Color fundus photograph: 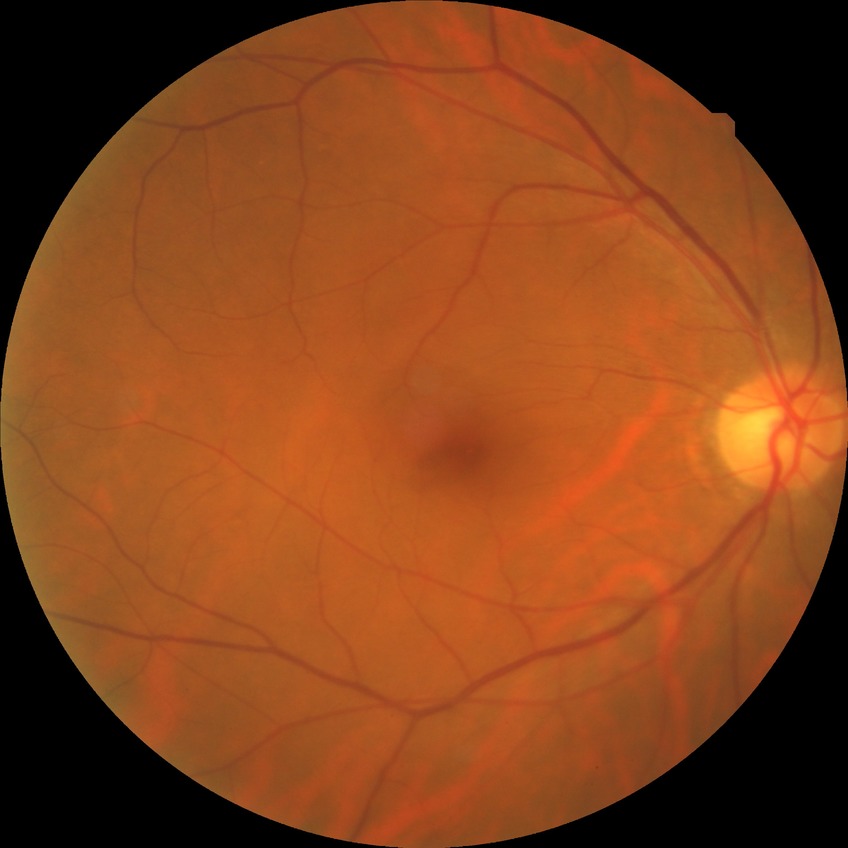

No signs of diabetic retinopathy.
Davis stage: NDR.